Fundus photo — 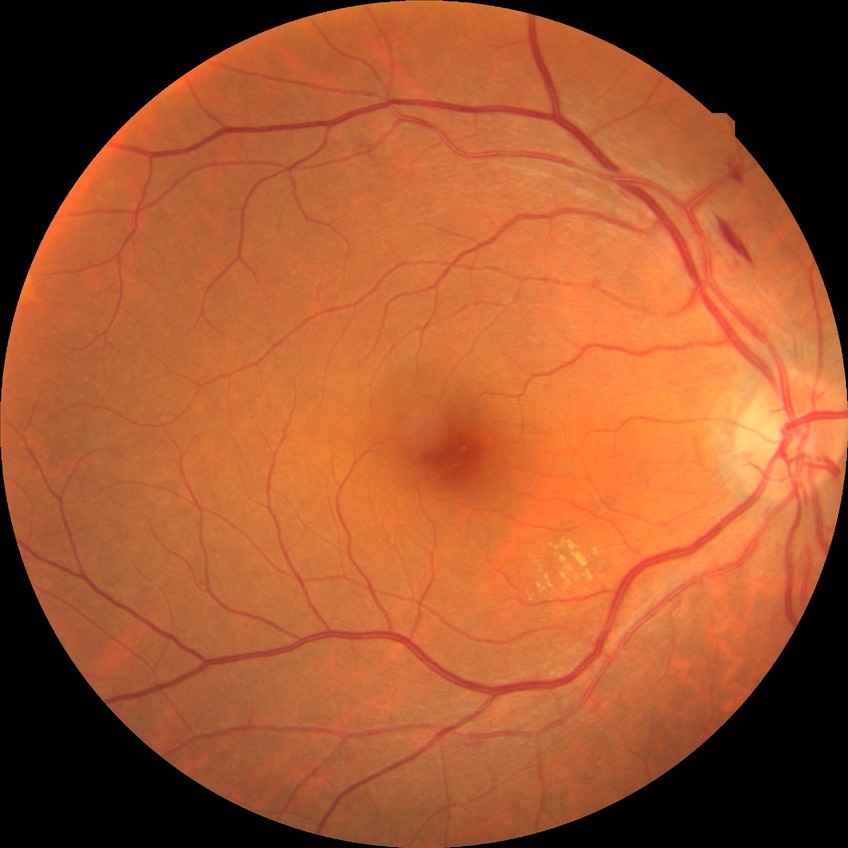
Diabetic retinopathy (DR) is simple diabetic retinopathy (SDR).
DR class: non-proliferative diabetic retinopathy.